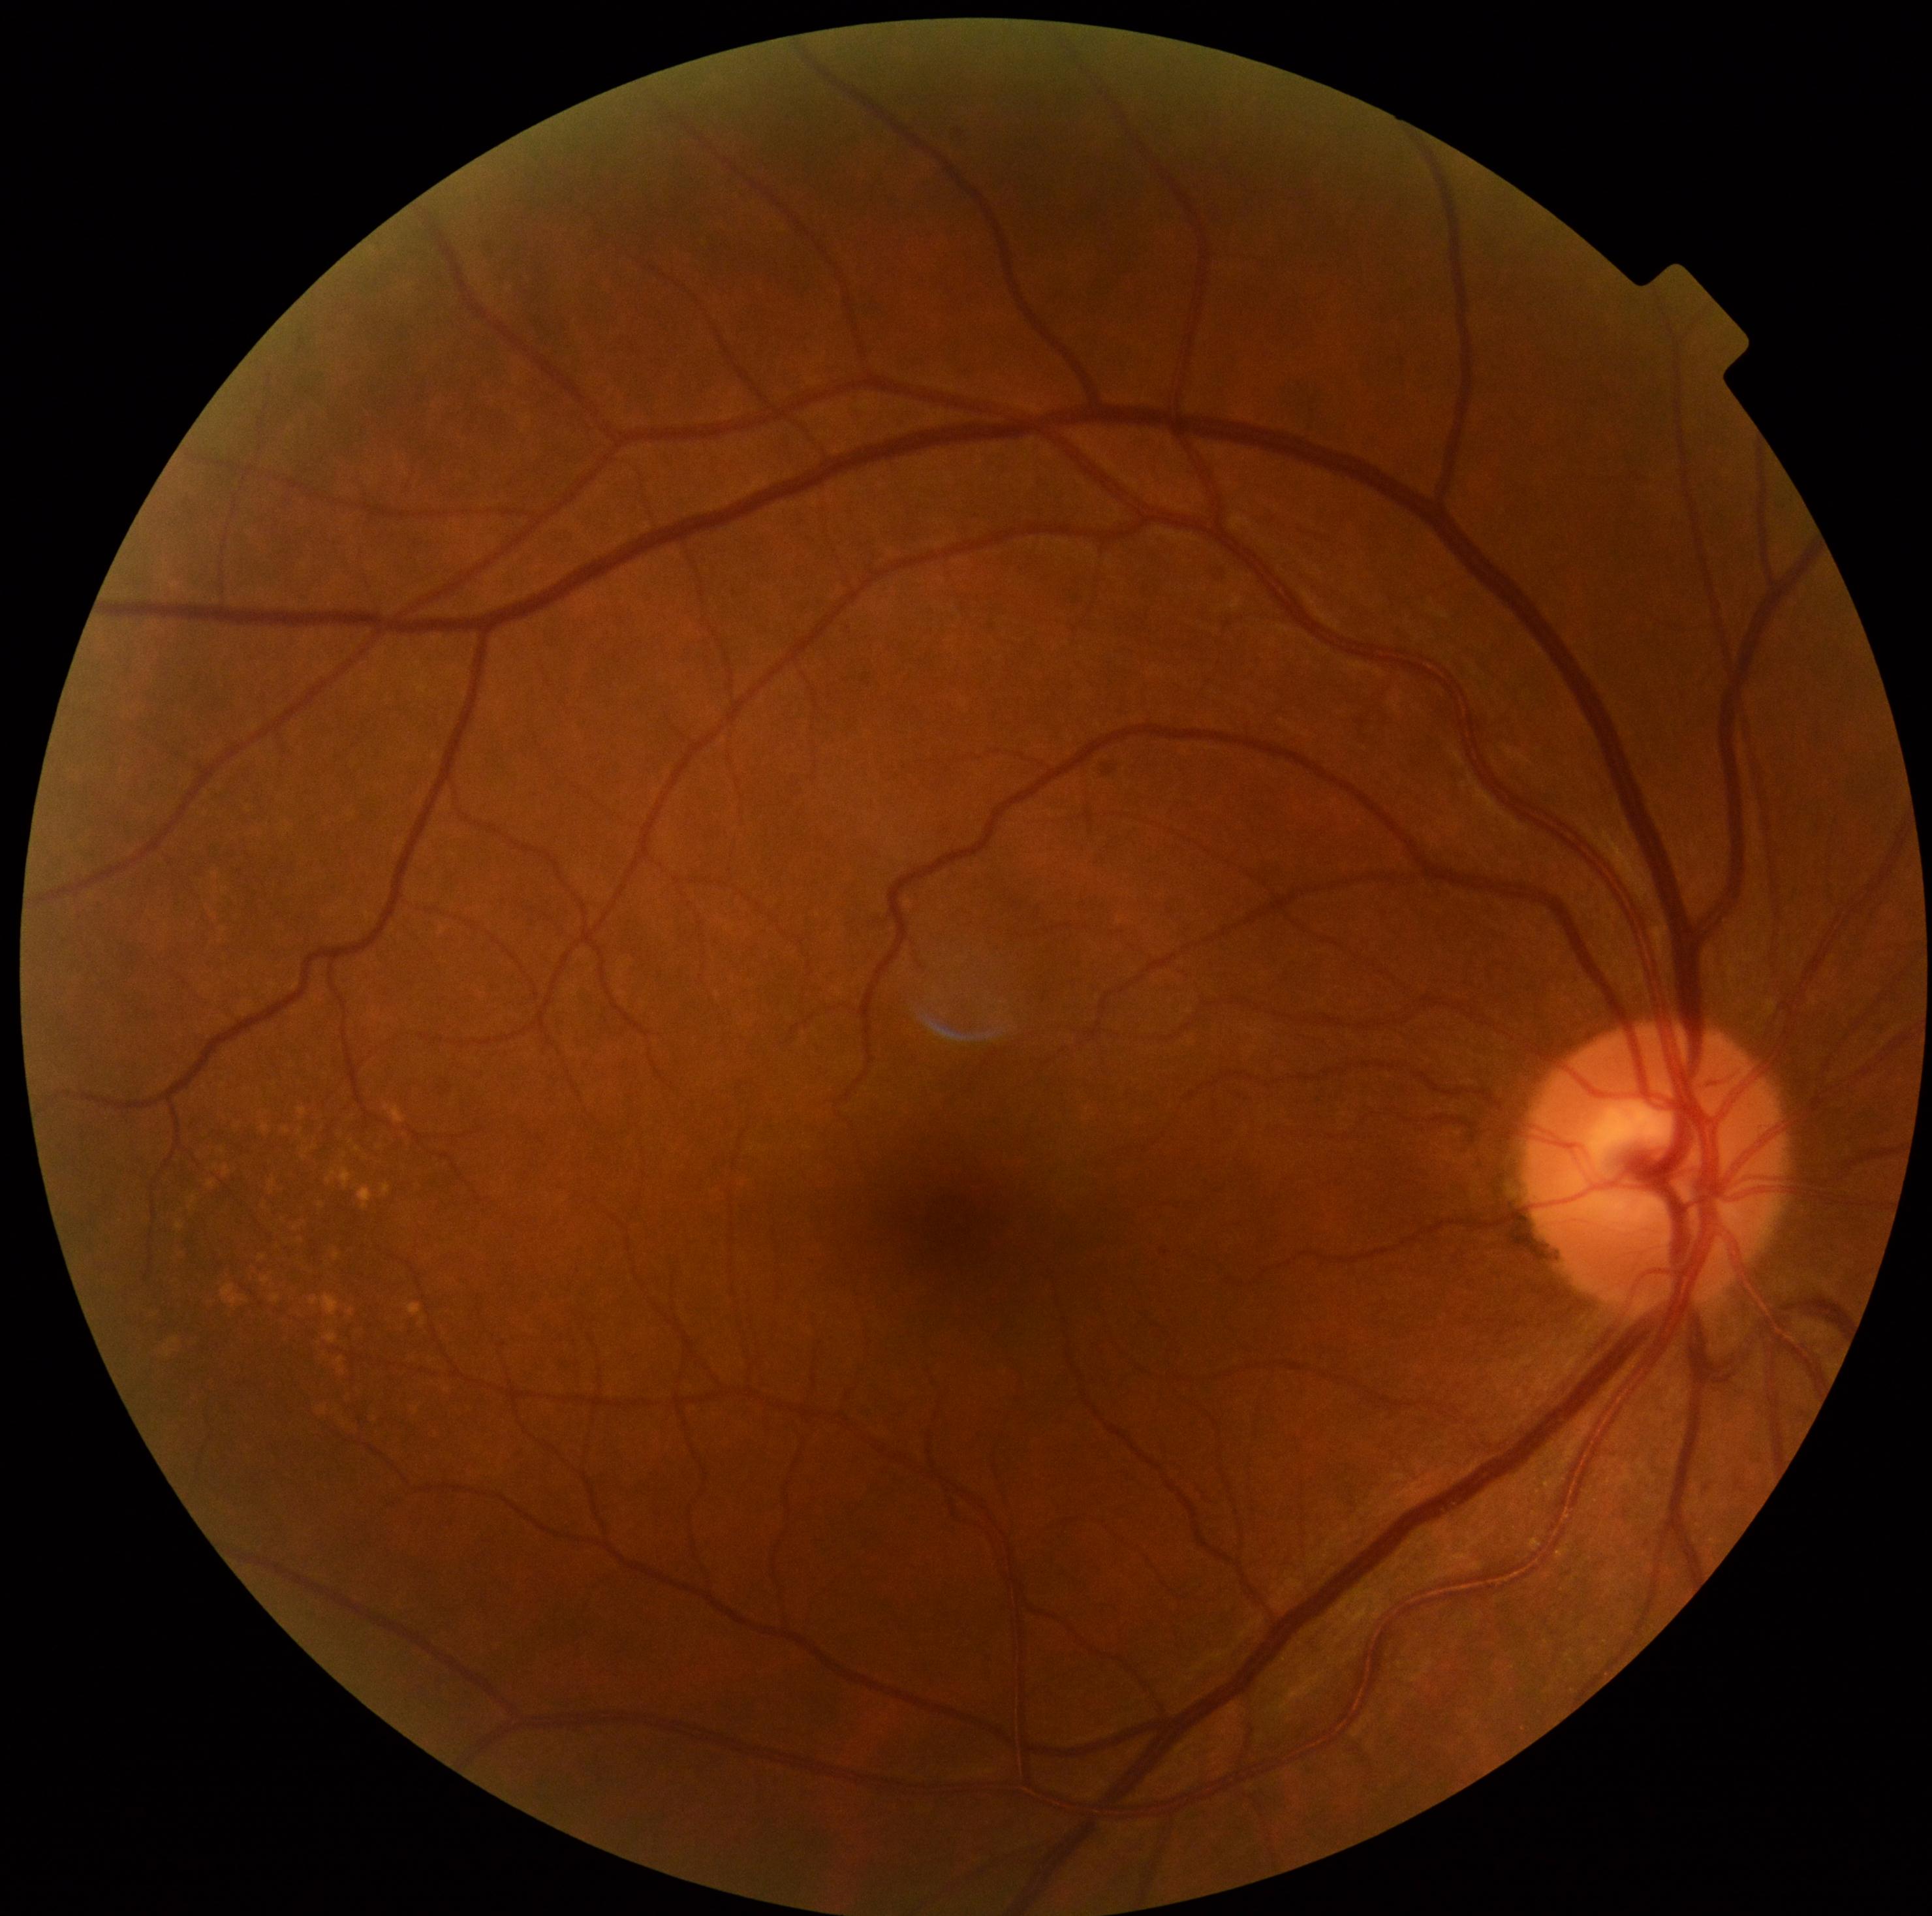
No apparent diabetic retinopathy. DR grade: 0/4.